Camera: NIDEK AFC-230; 848x848.
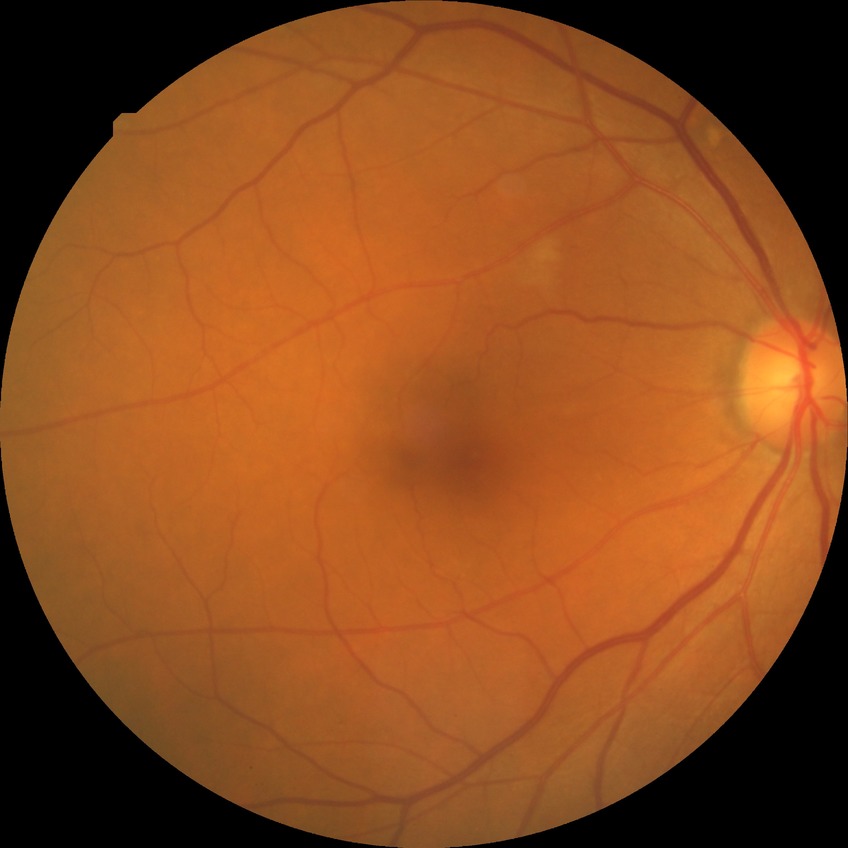
Diabetic retinopathy (DR) is no diabetic retinopathy (NDR).